Image size 848x848, color fundus photograph, modified Davis grading, 45 degree fundus photograph — 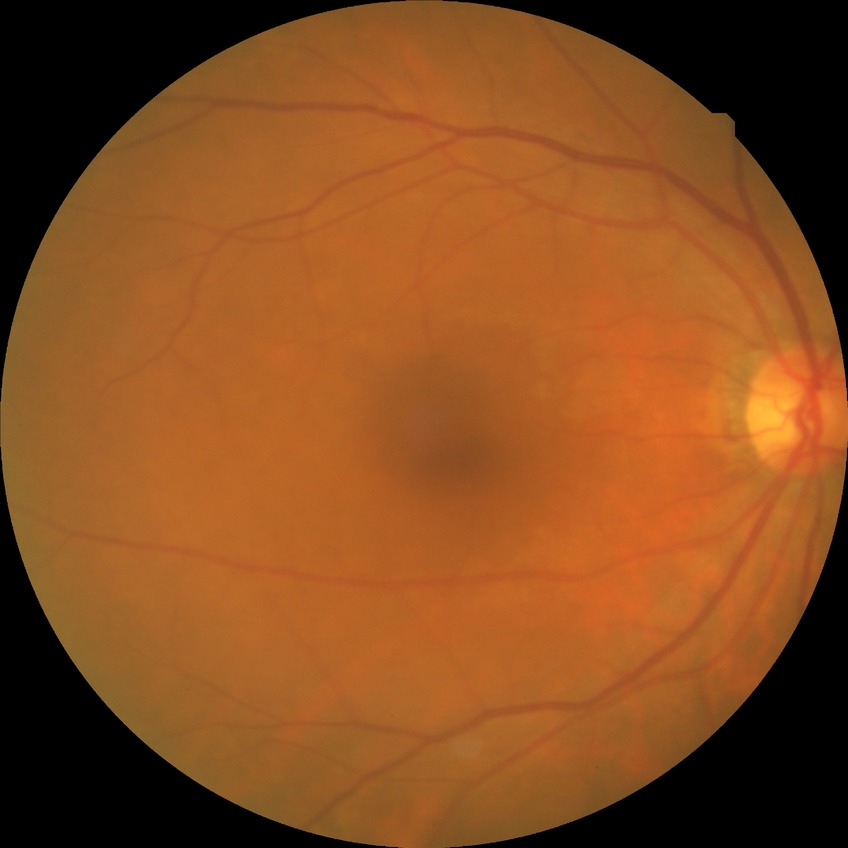

Davis DR grade: NDR, DR impression: negative for DR.